848 x 848 pixels, without pupil dilation.
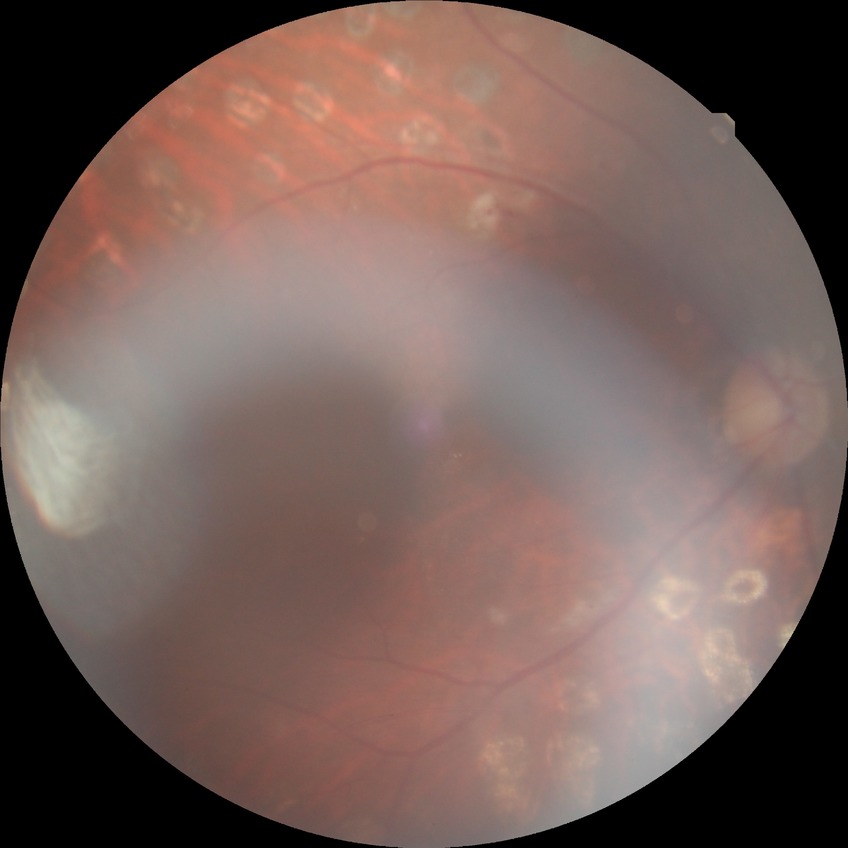 Findings:
– DR grade: PDR